Acquired on the Natus RetCam Envision. 1440x1080. Infant wide-field retinal image — 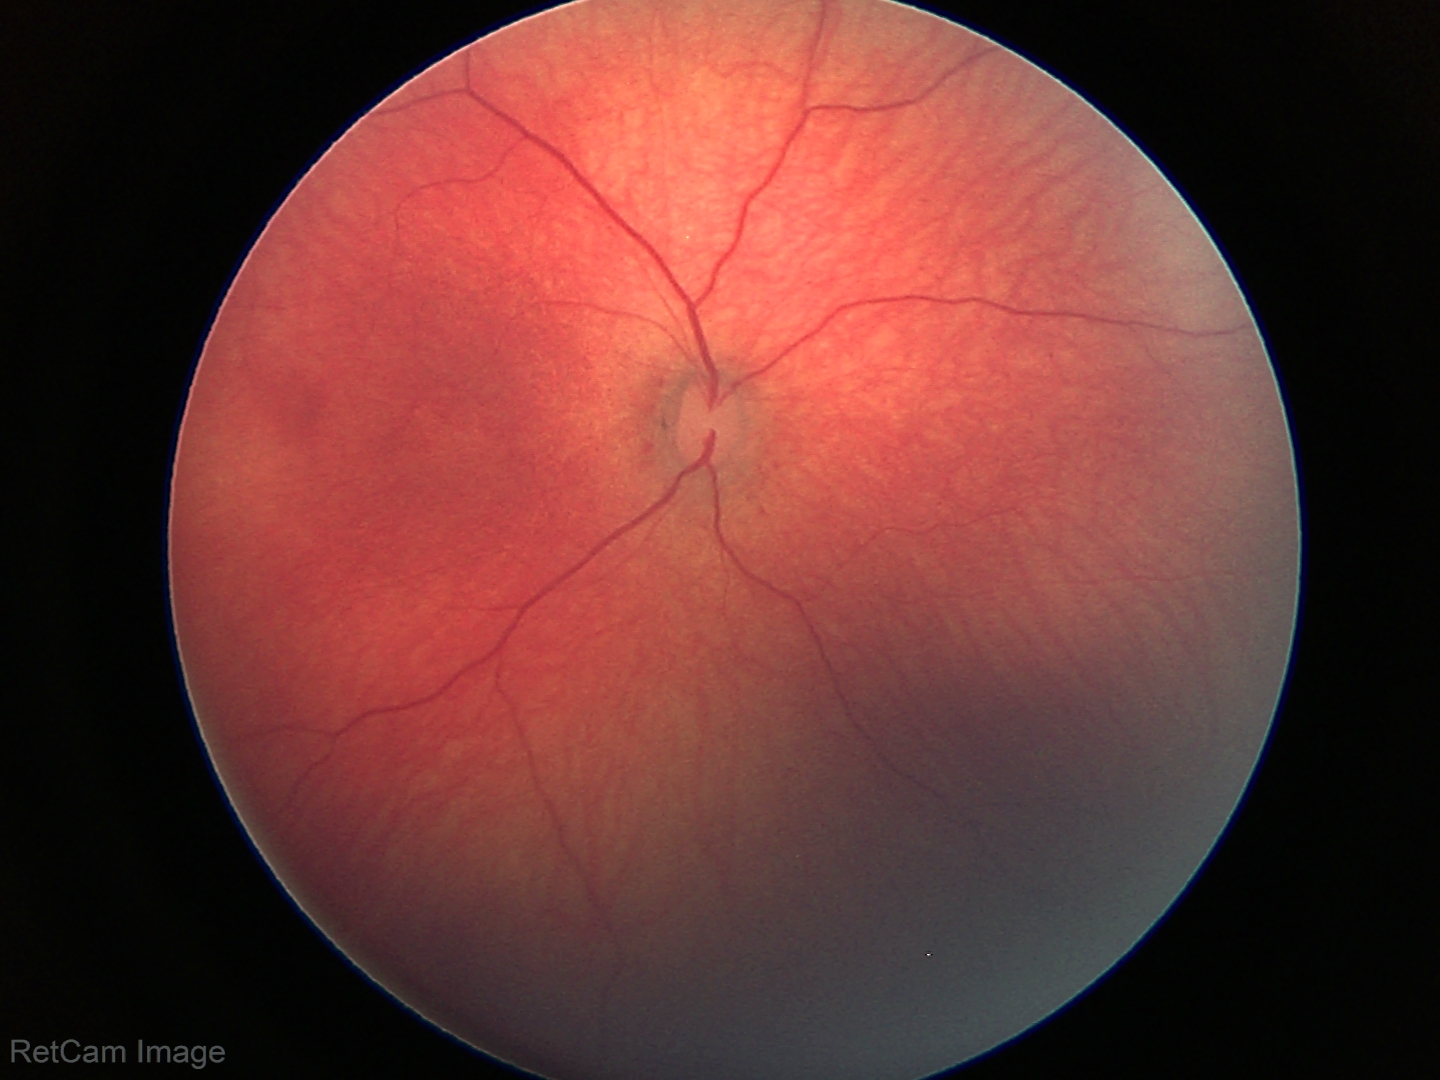 Normal screening examination.